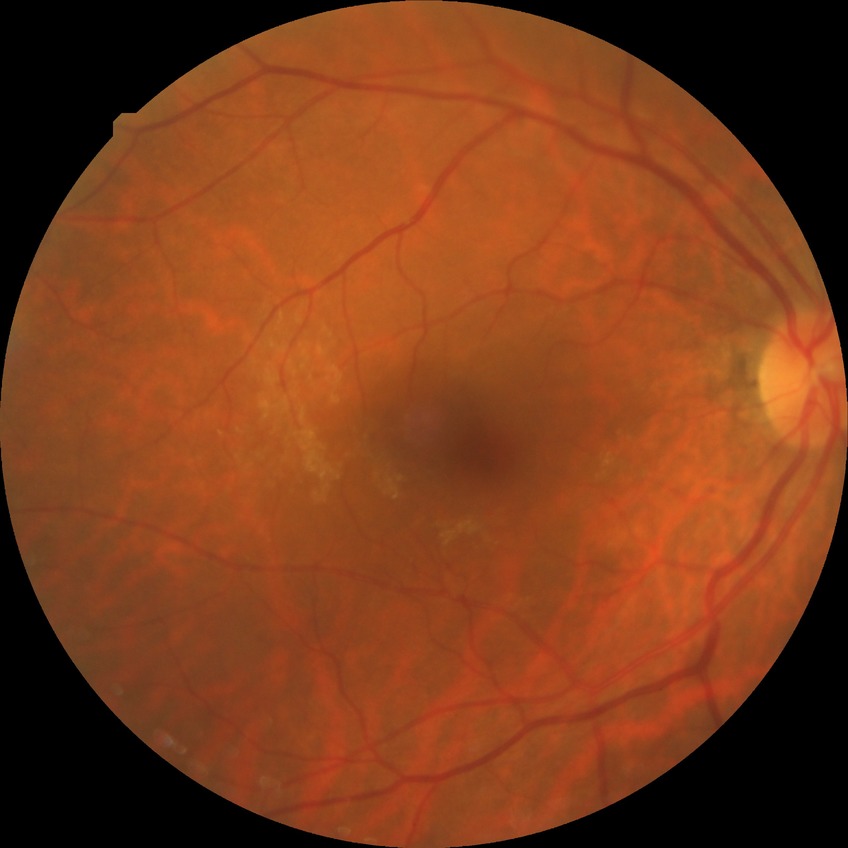

Diabetic retinopathy (DR): NDR (no diabetic retinopathy).